2089x1764.
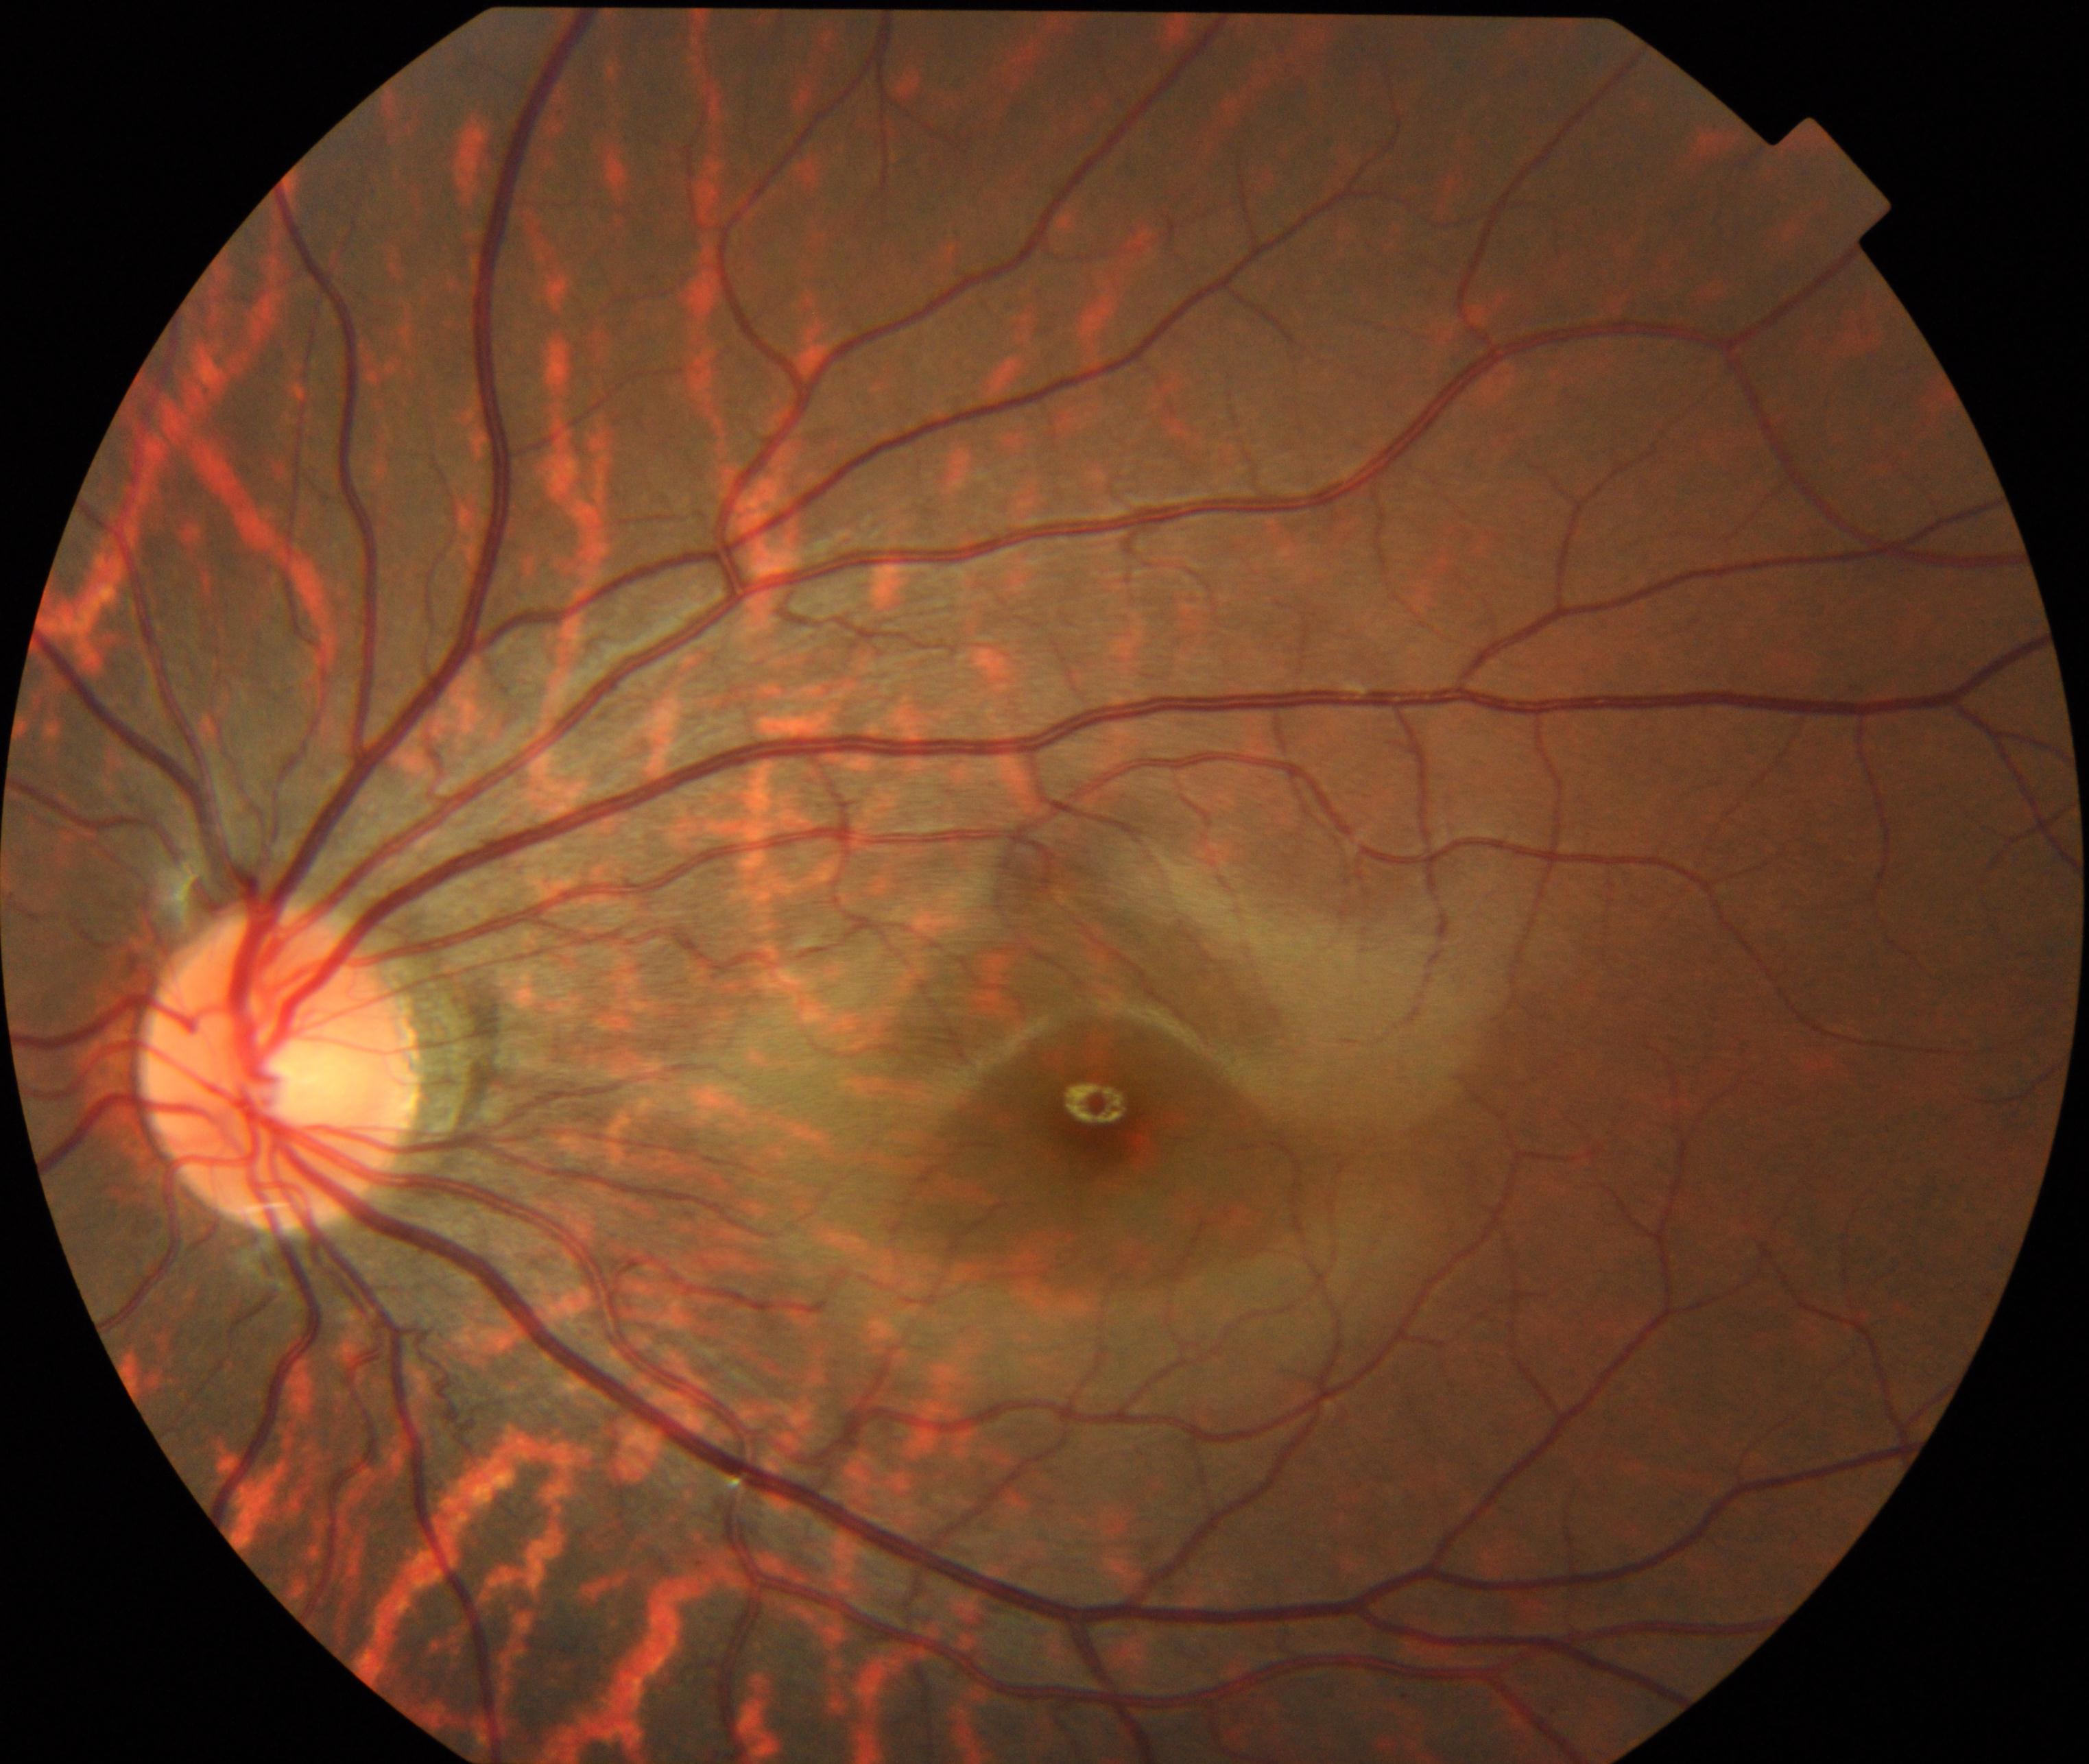
Fundus image consistent with tessellated fundus.